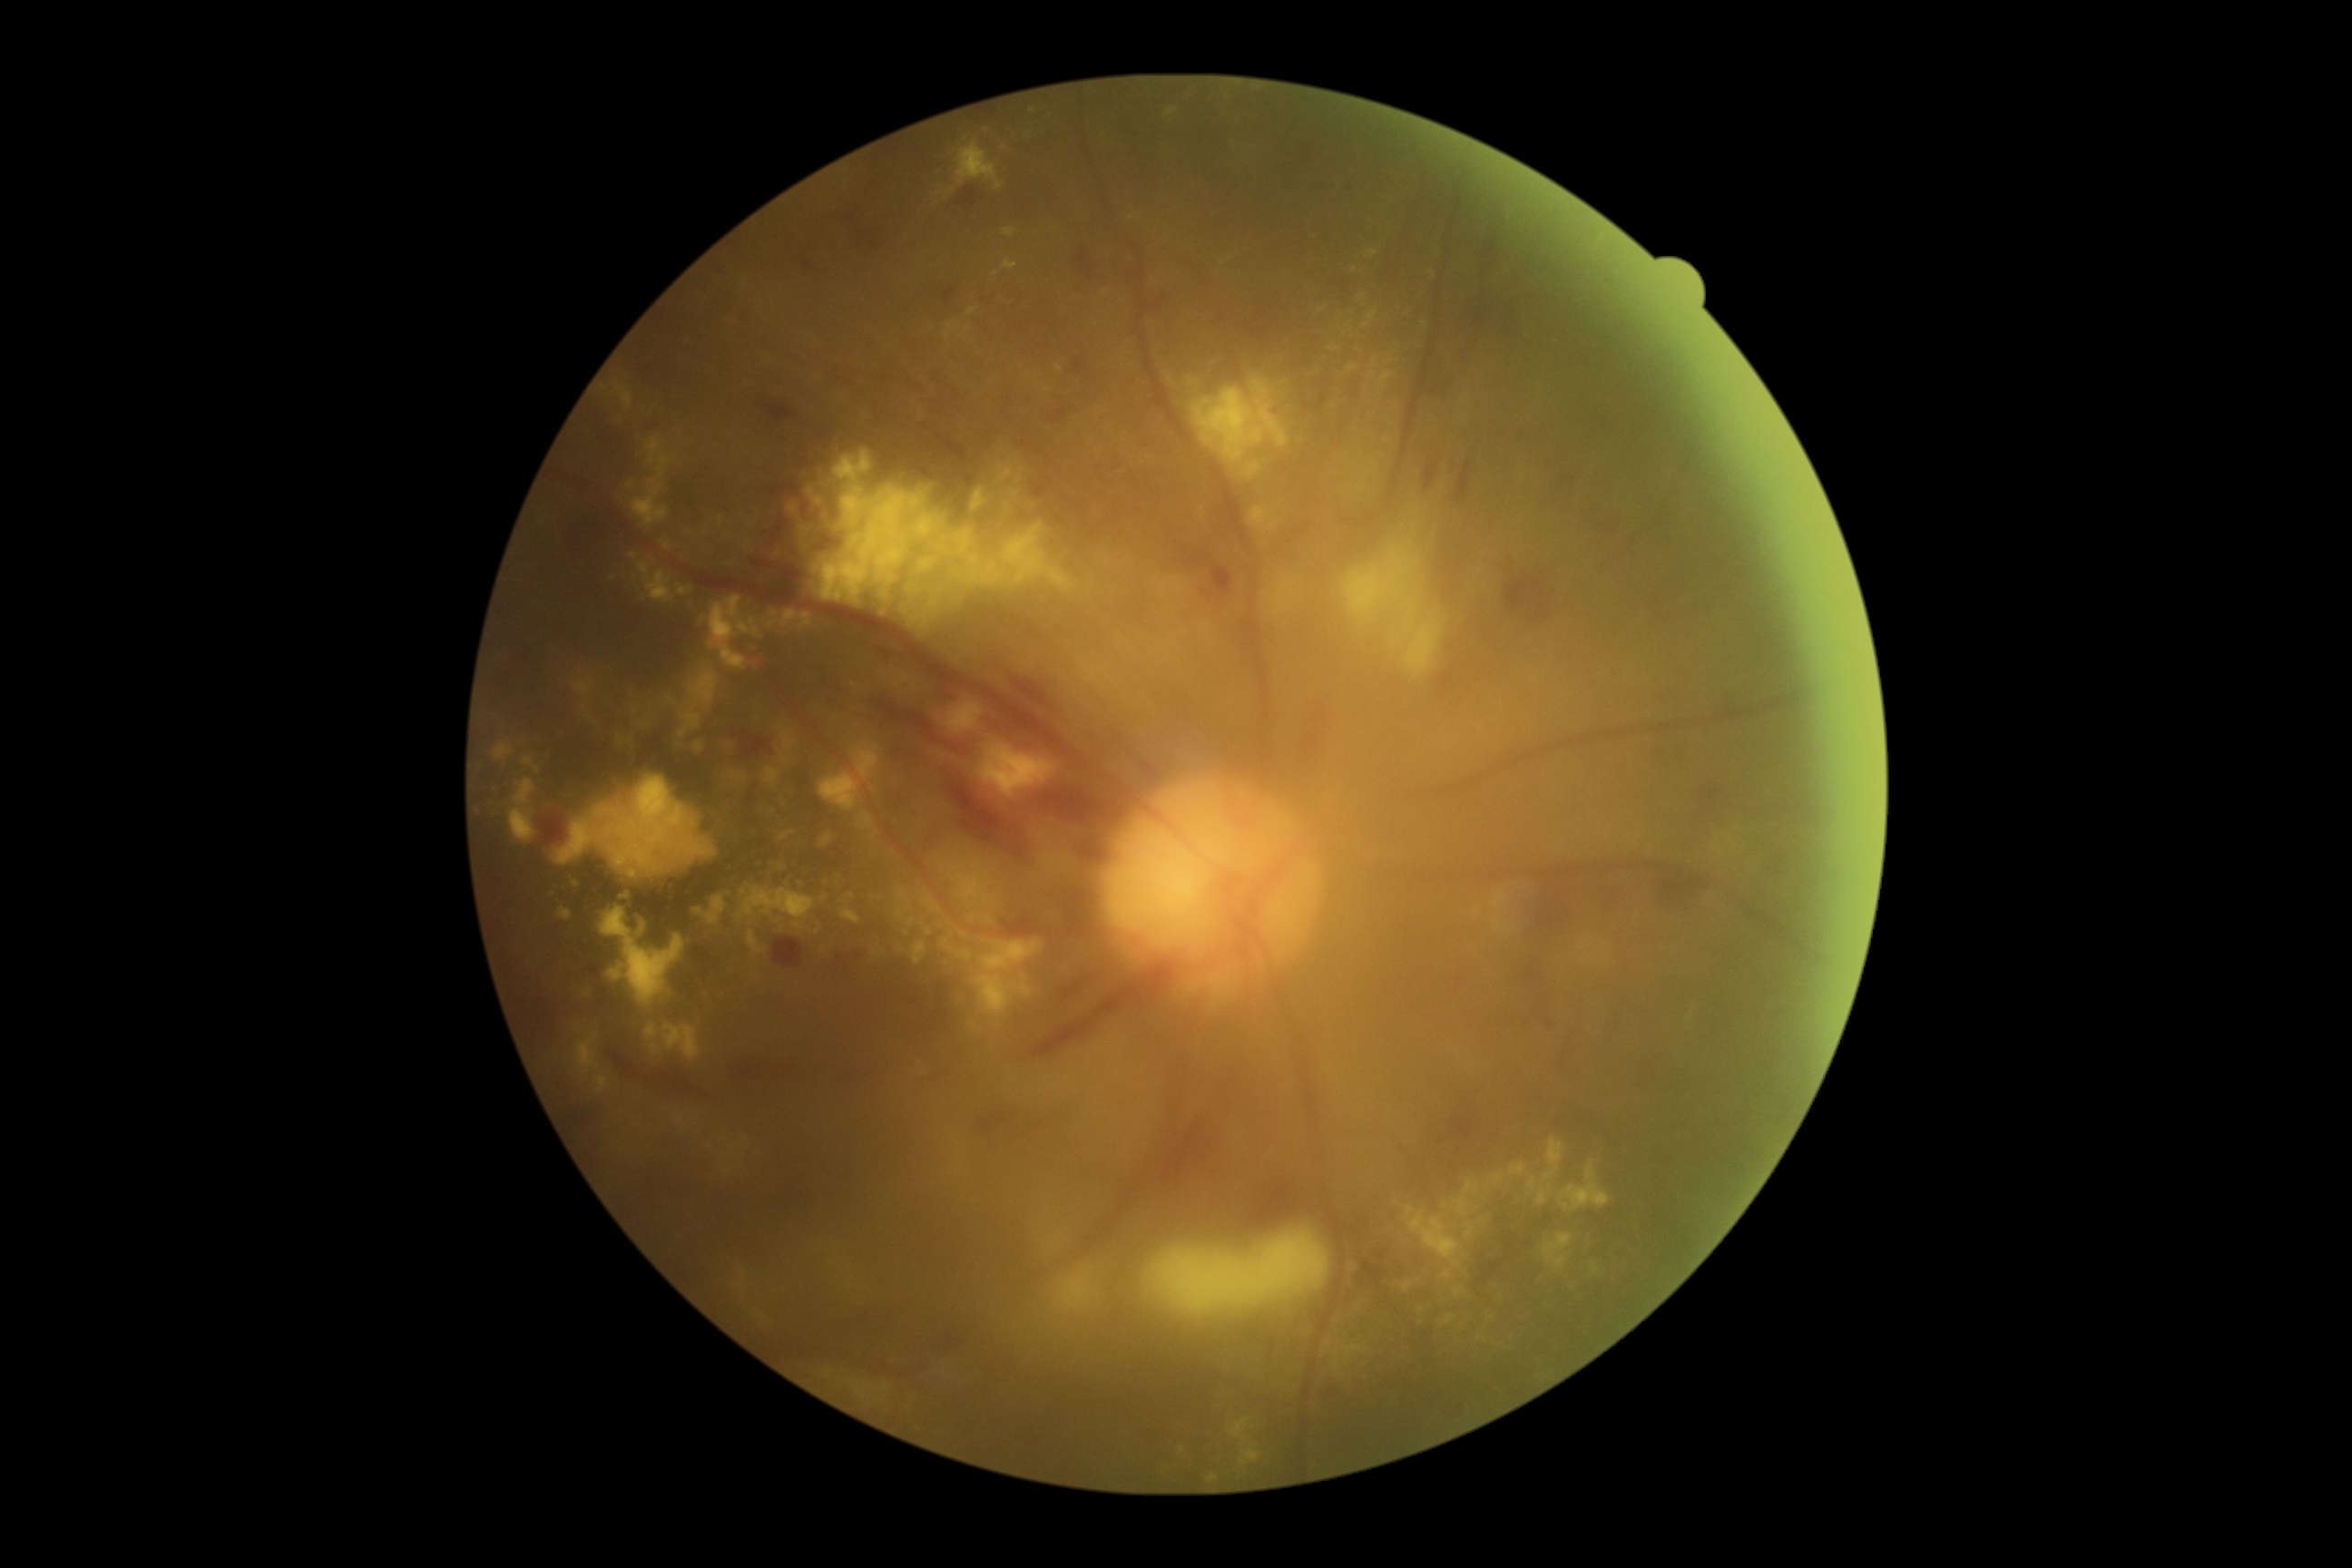
The retinopathy is classified as non-proliferative diabetic retinopathy. Diabetic retinopathy (DR): 3/4.